Captured on a Remidio Fundus on Phone — 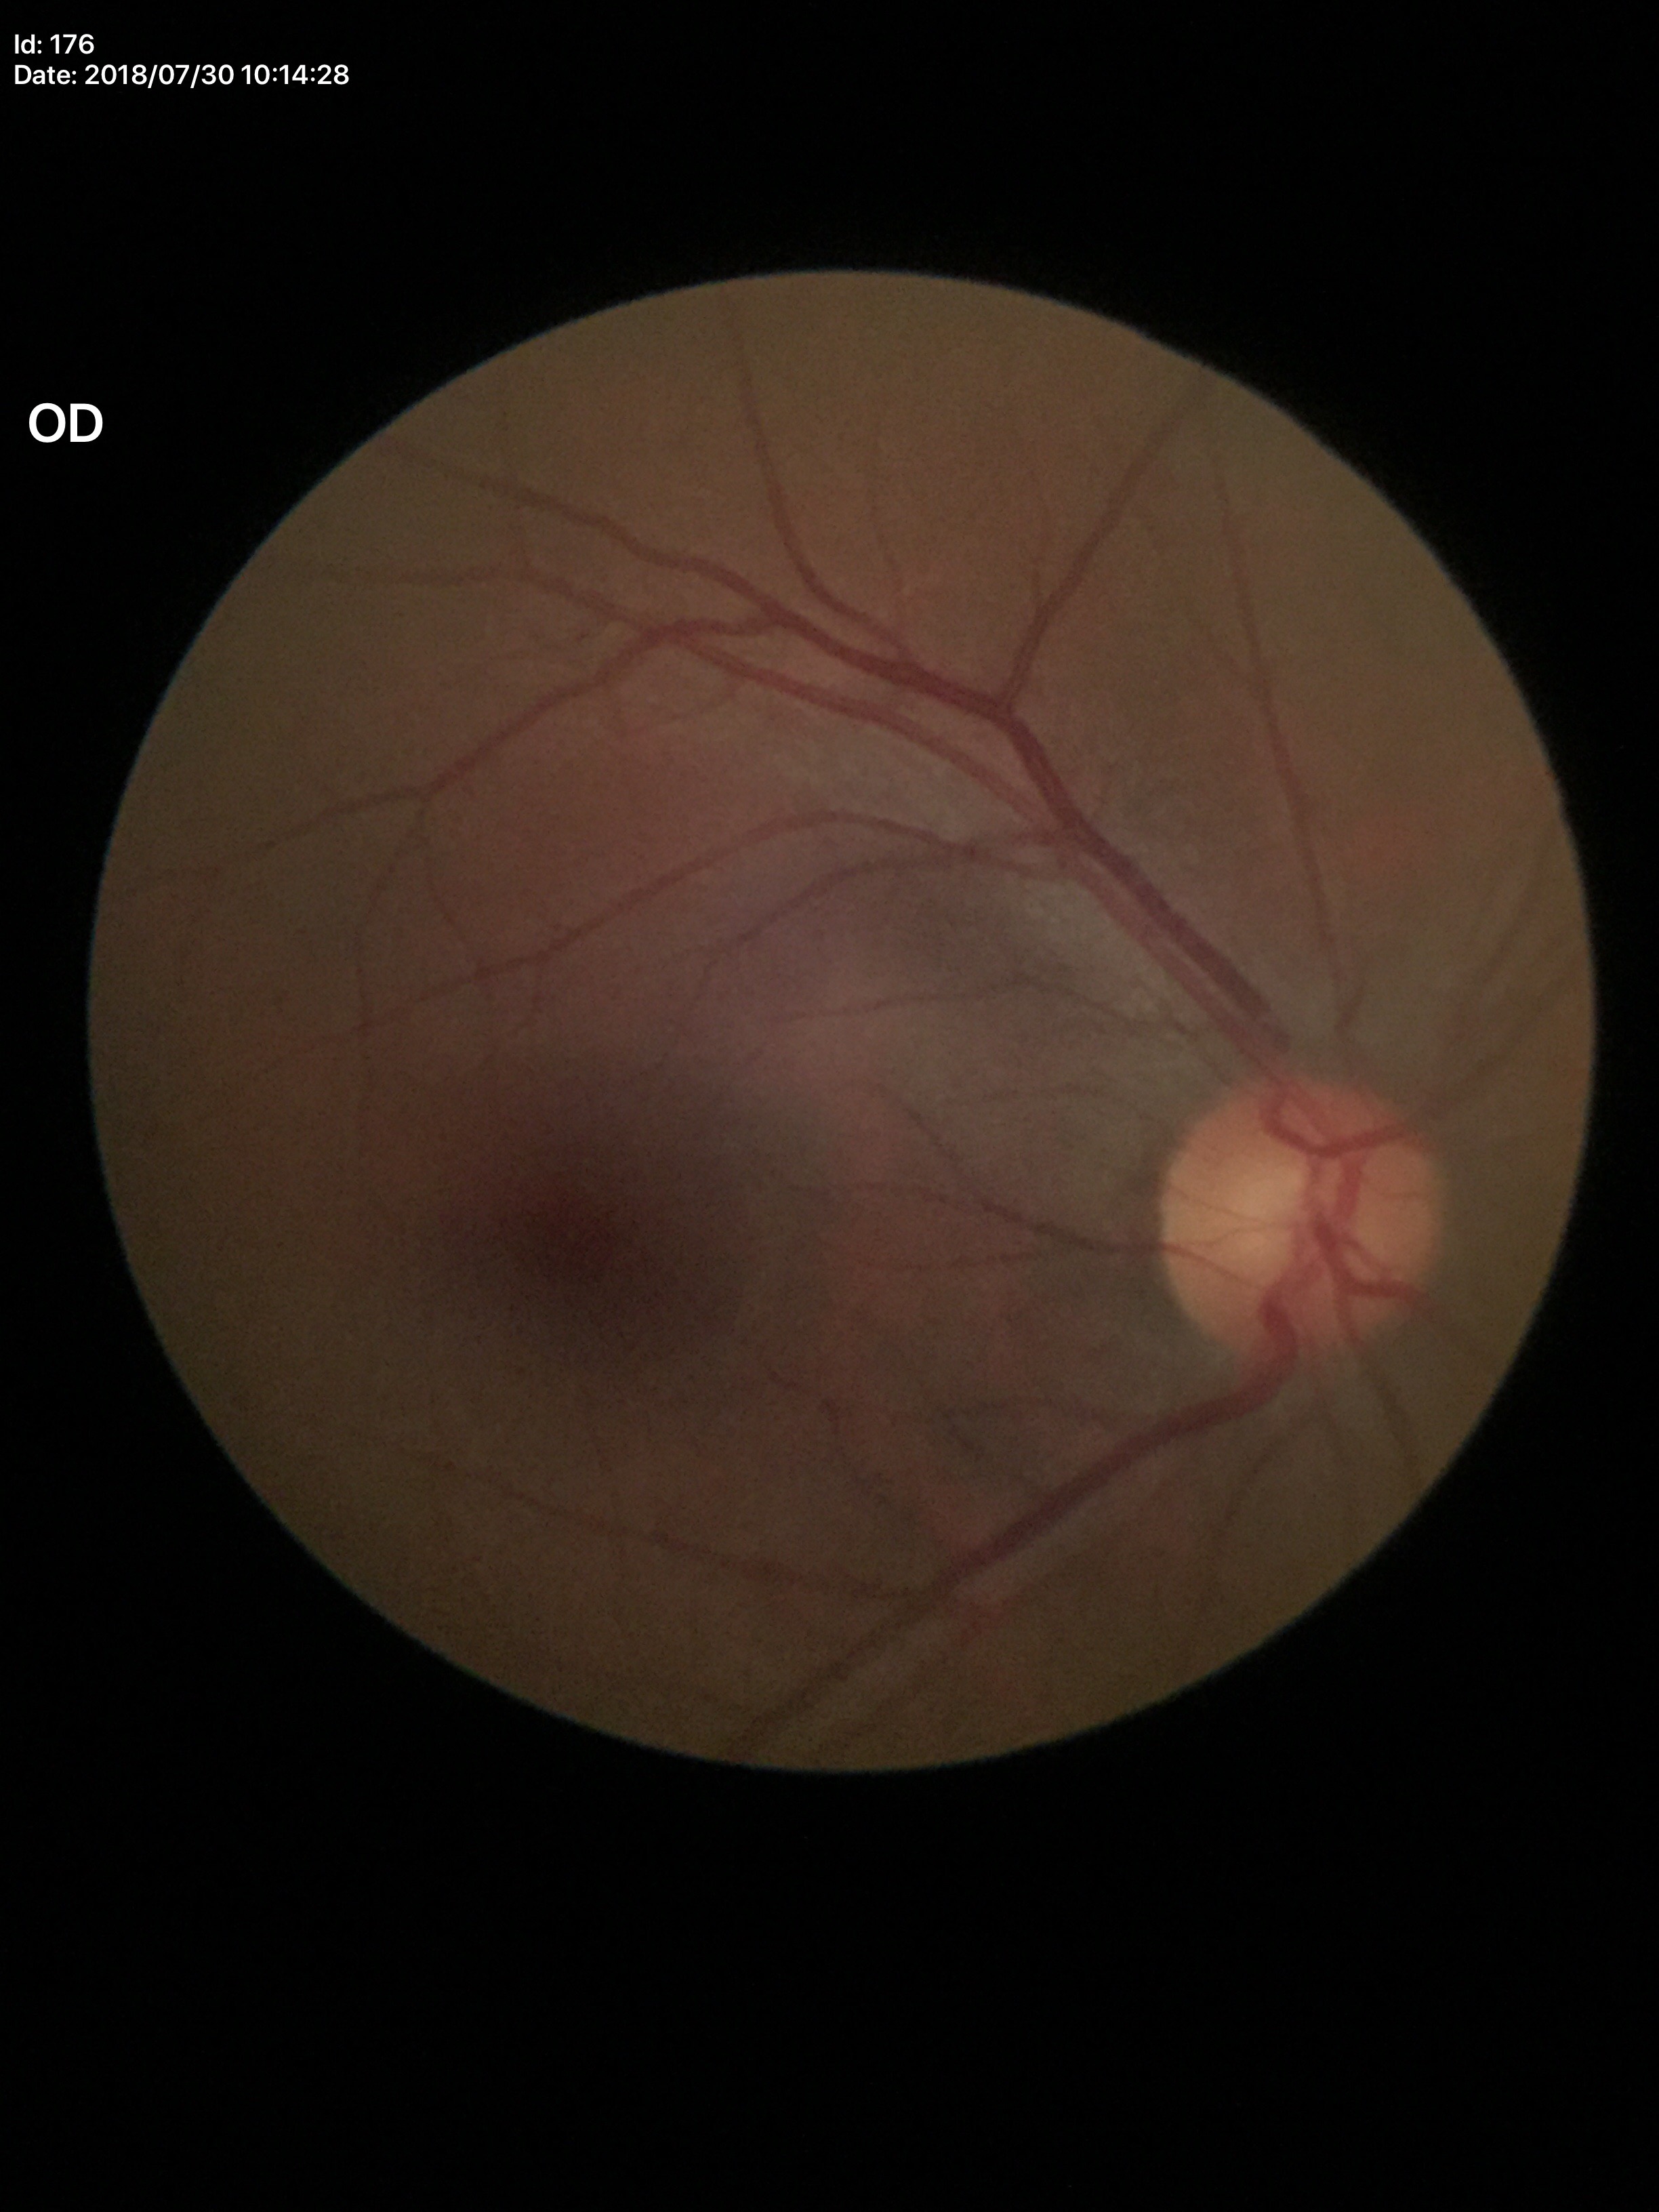

Horizontal C/D ratio: 0.50. Glaucoma assessment: negative (5/5 ophthalmologists in agreement). Vertical C/D ratio of 0.53.